Wide-field contact fundus photograph of an infant; Natus RetCam Envision, 130° FOV
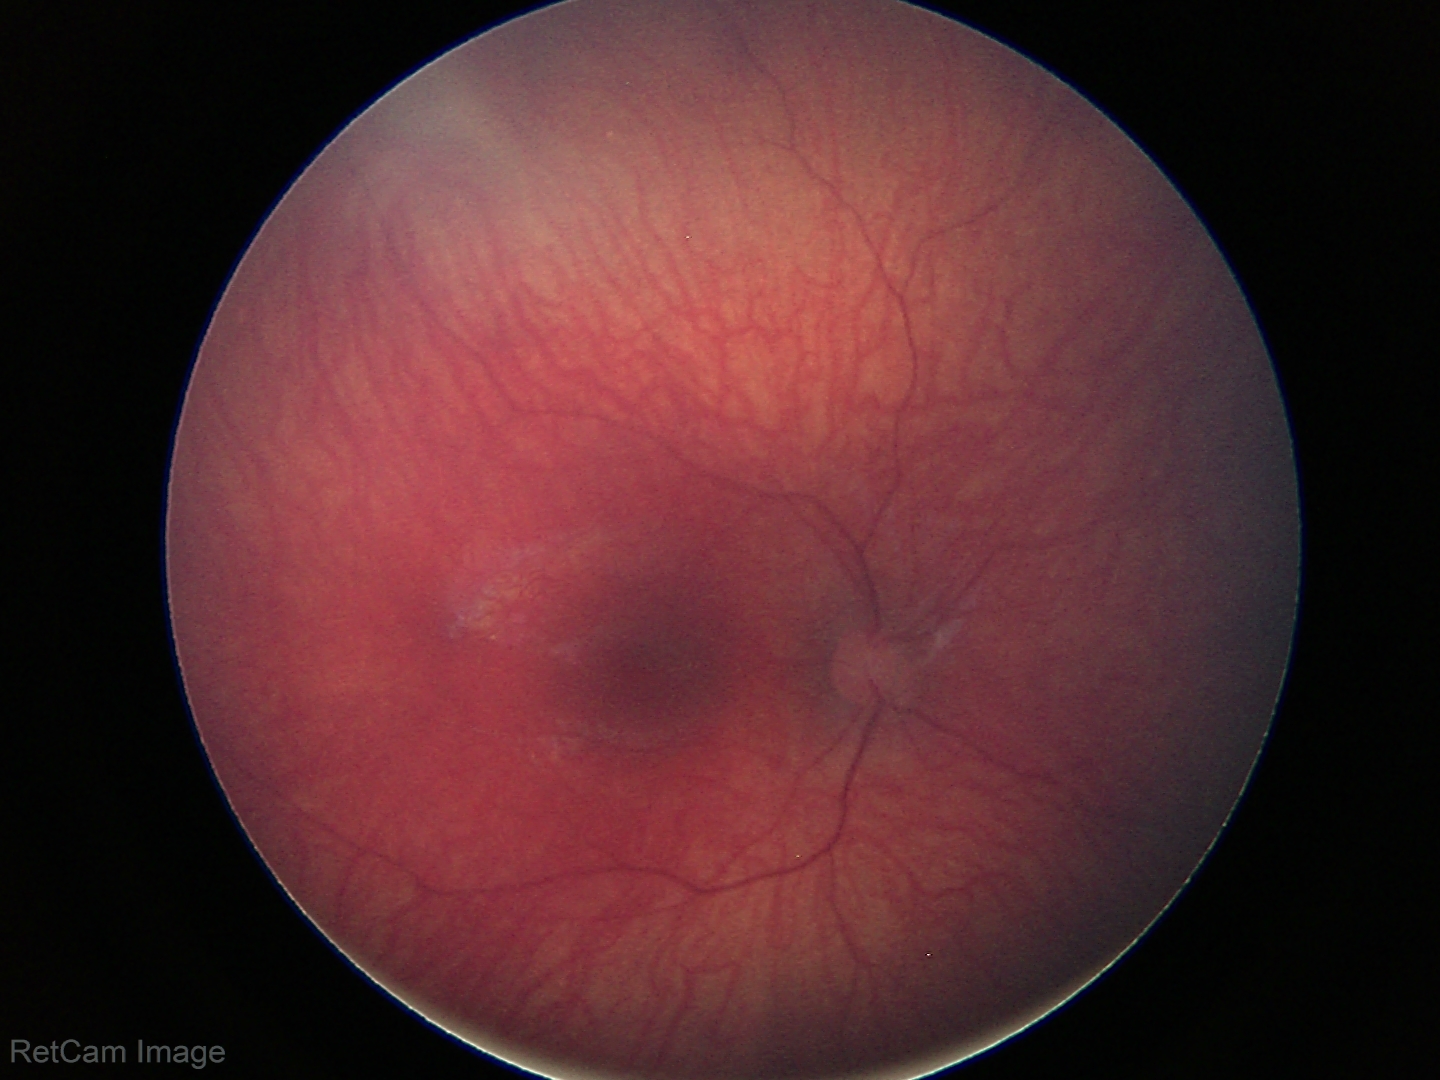
Assessment = no abnormalities.